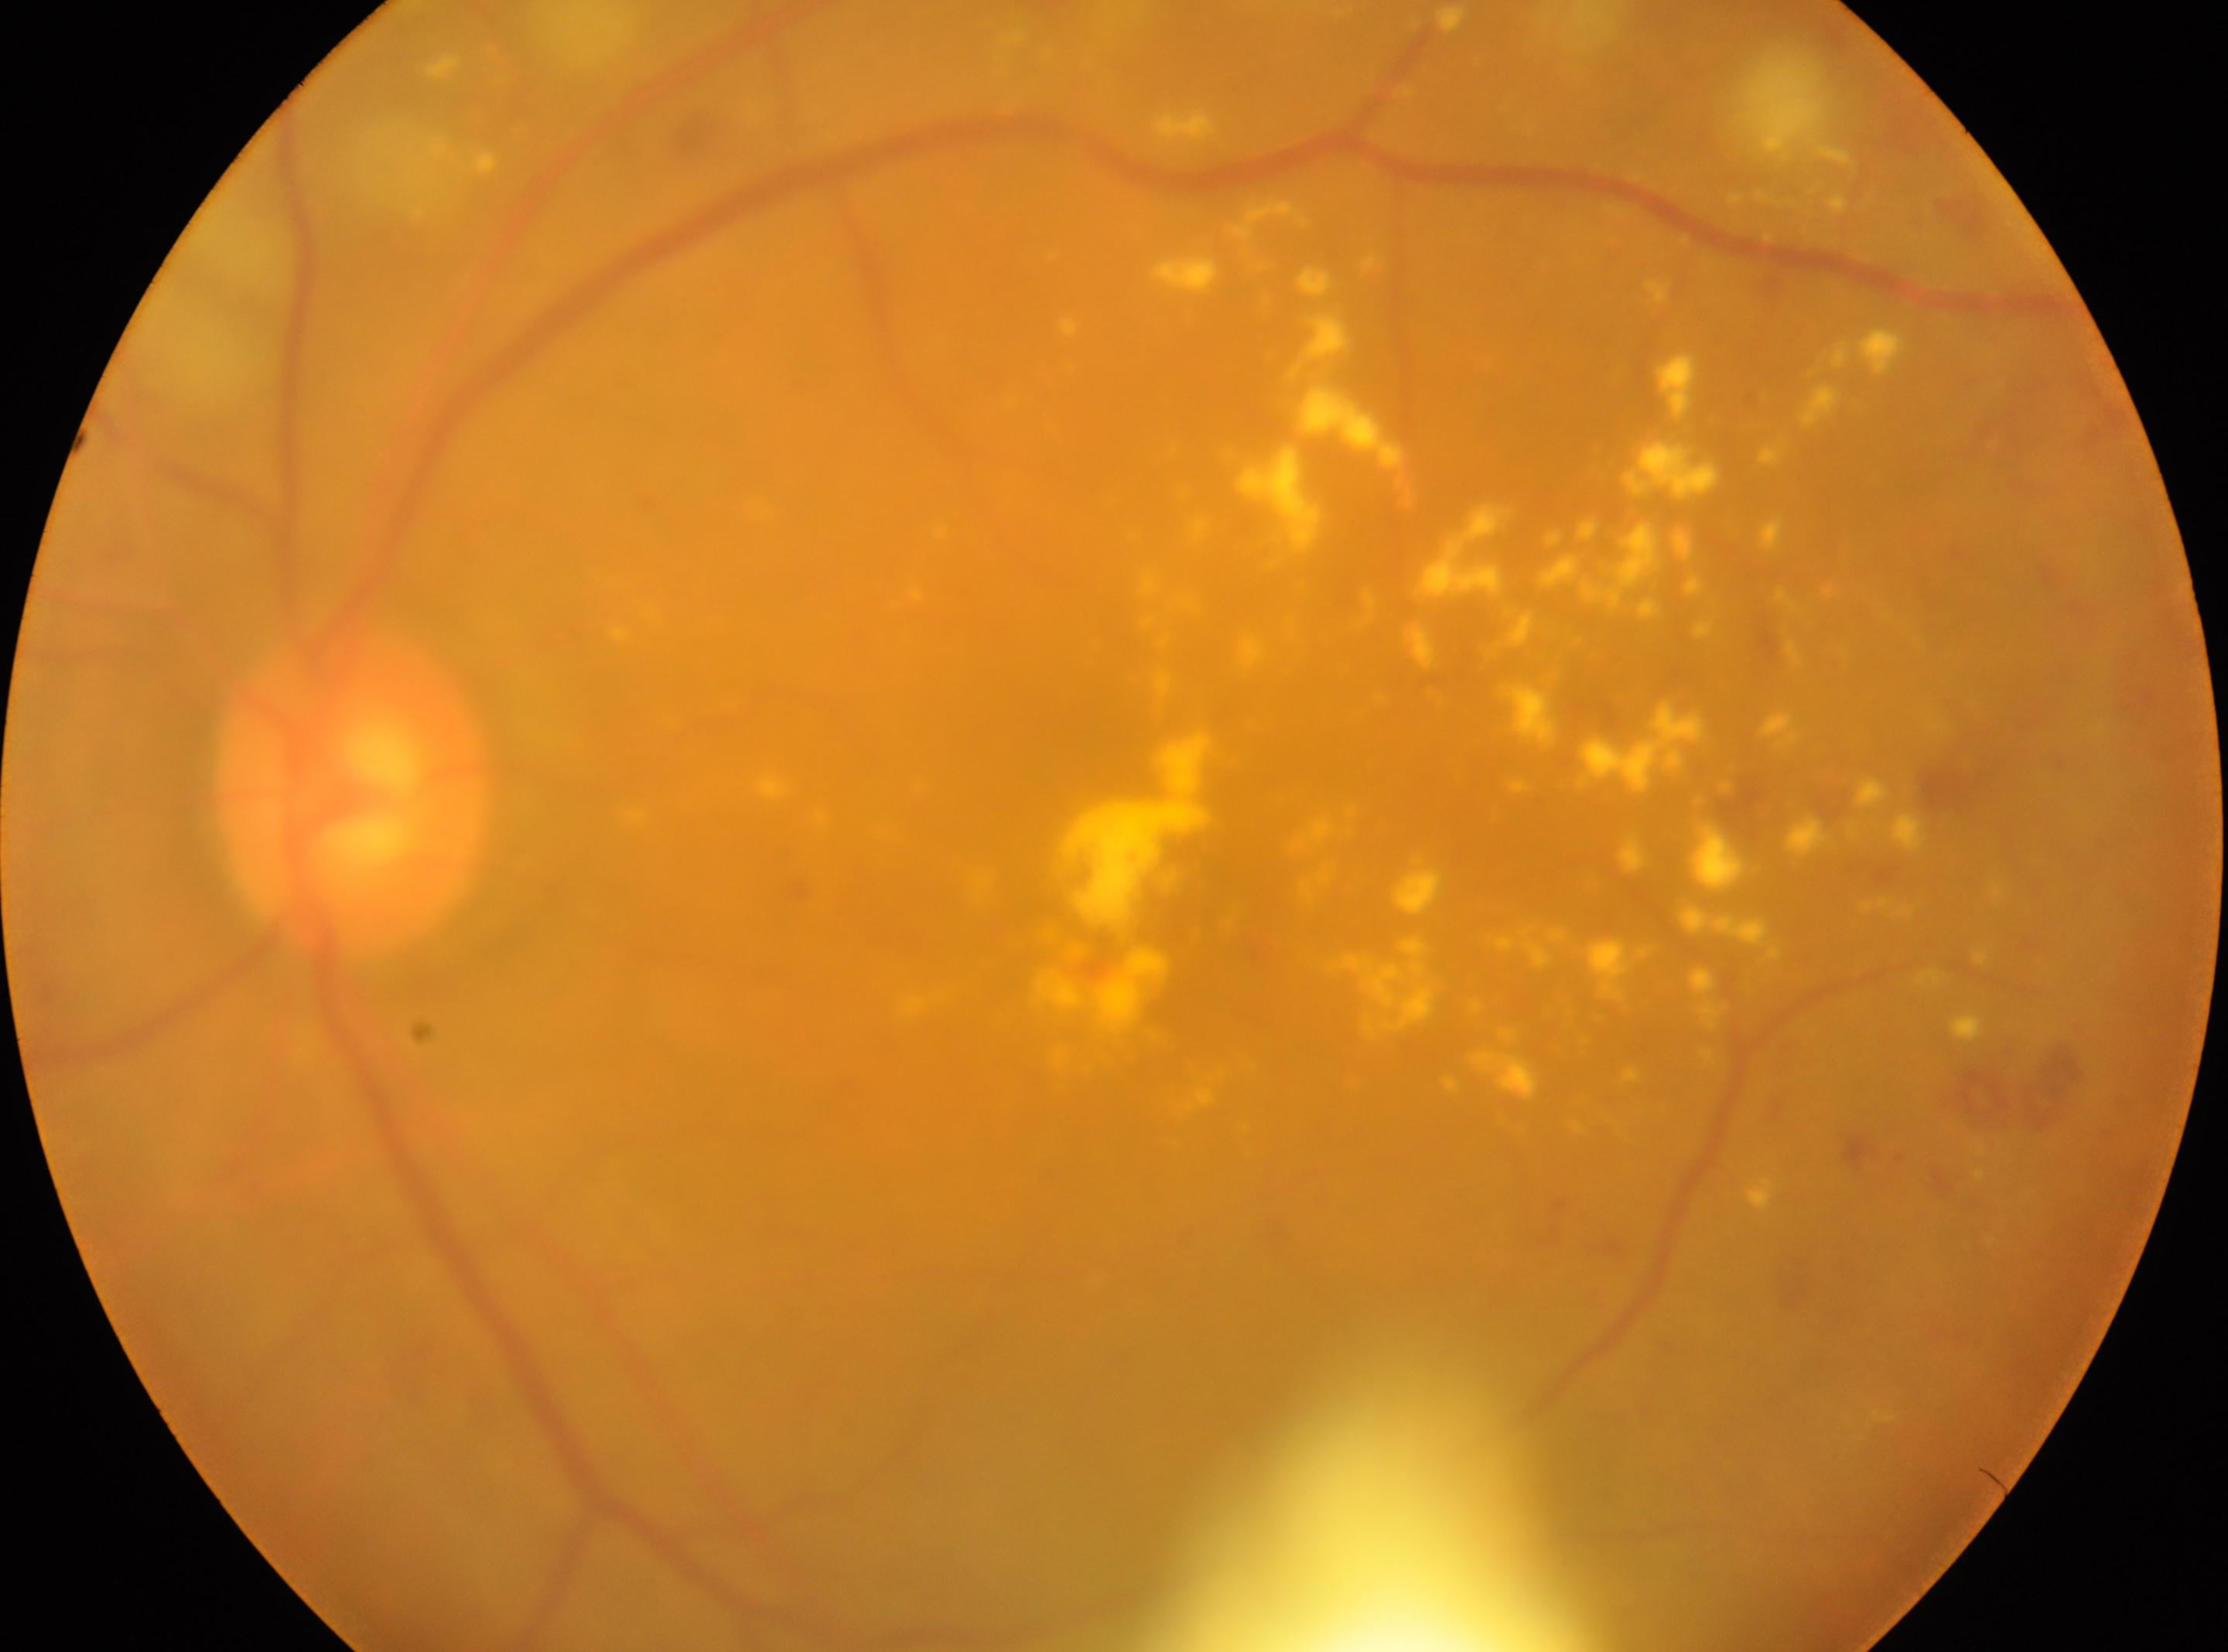 DR severity: 2. This is the oculus sinister. The optic disk is at (353,794). The macular center is at (1154,927).